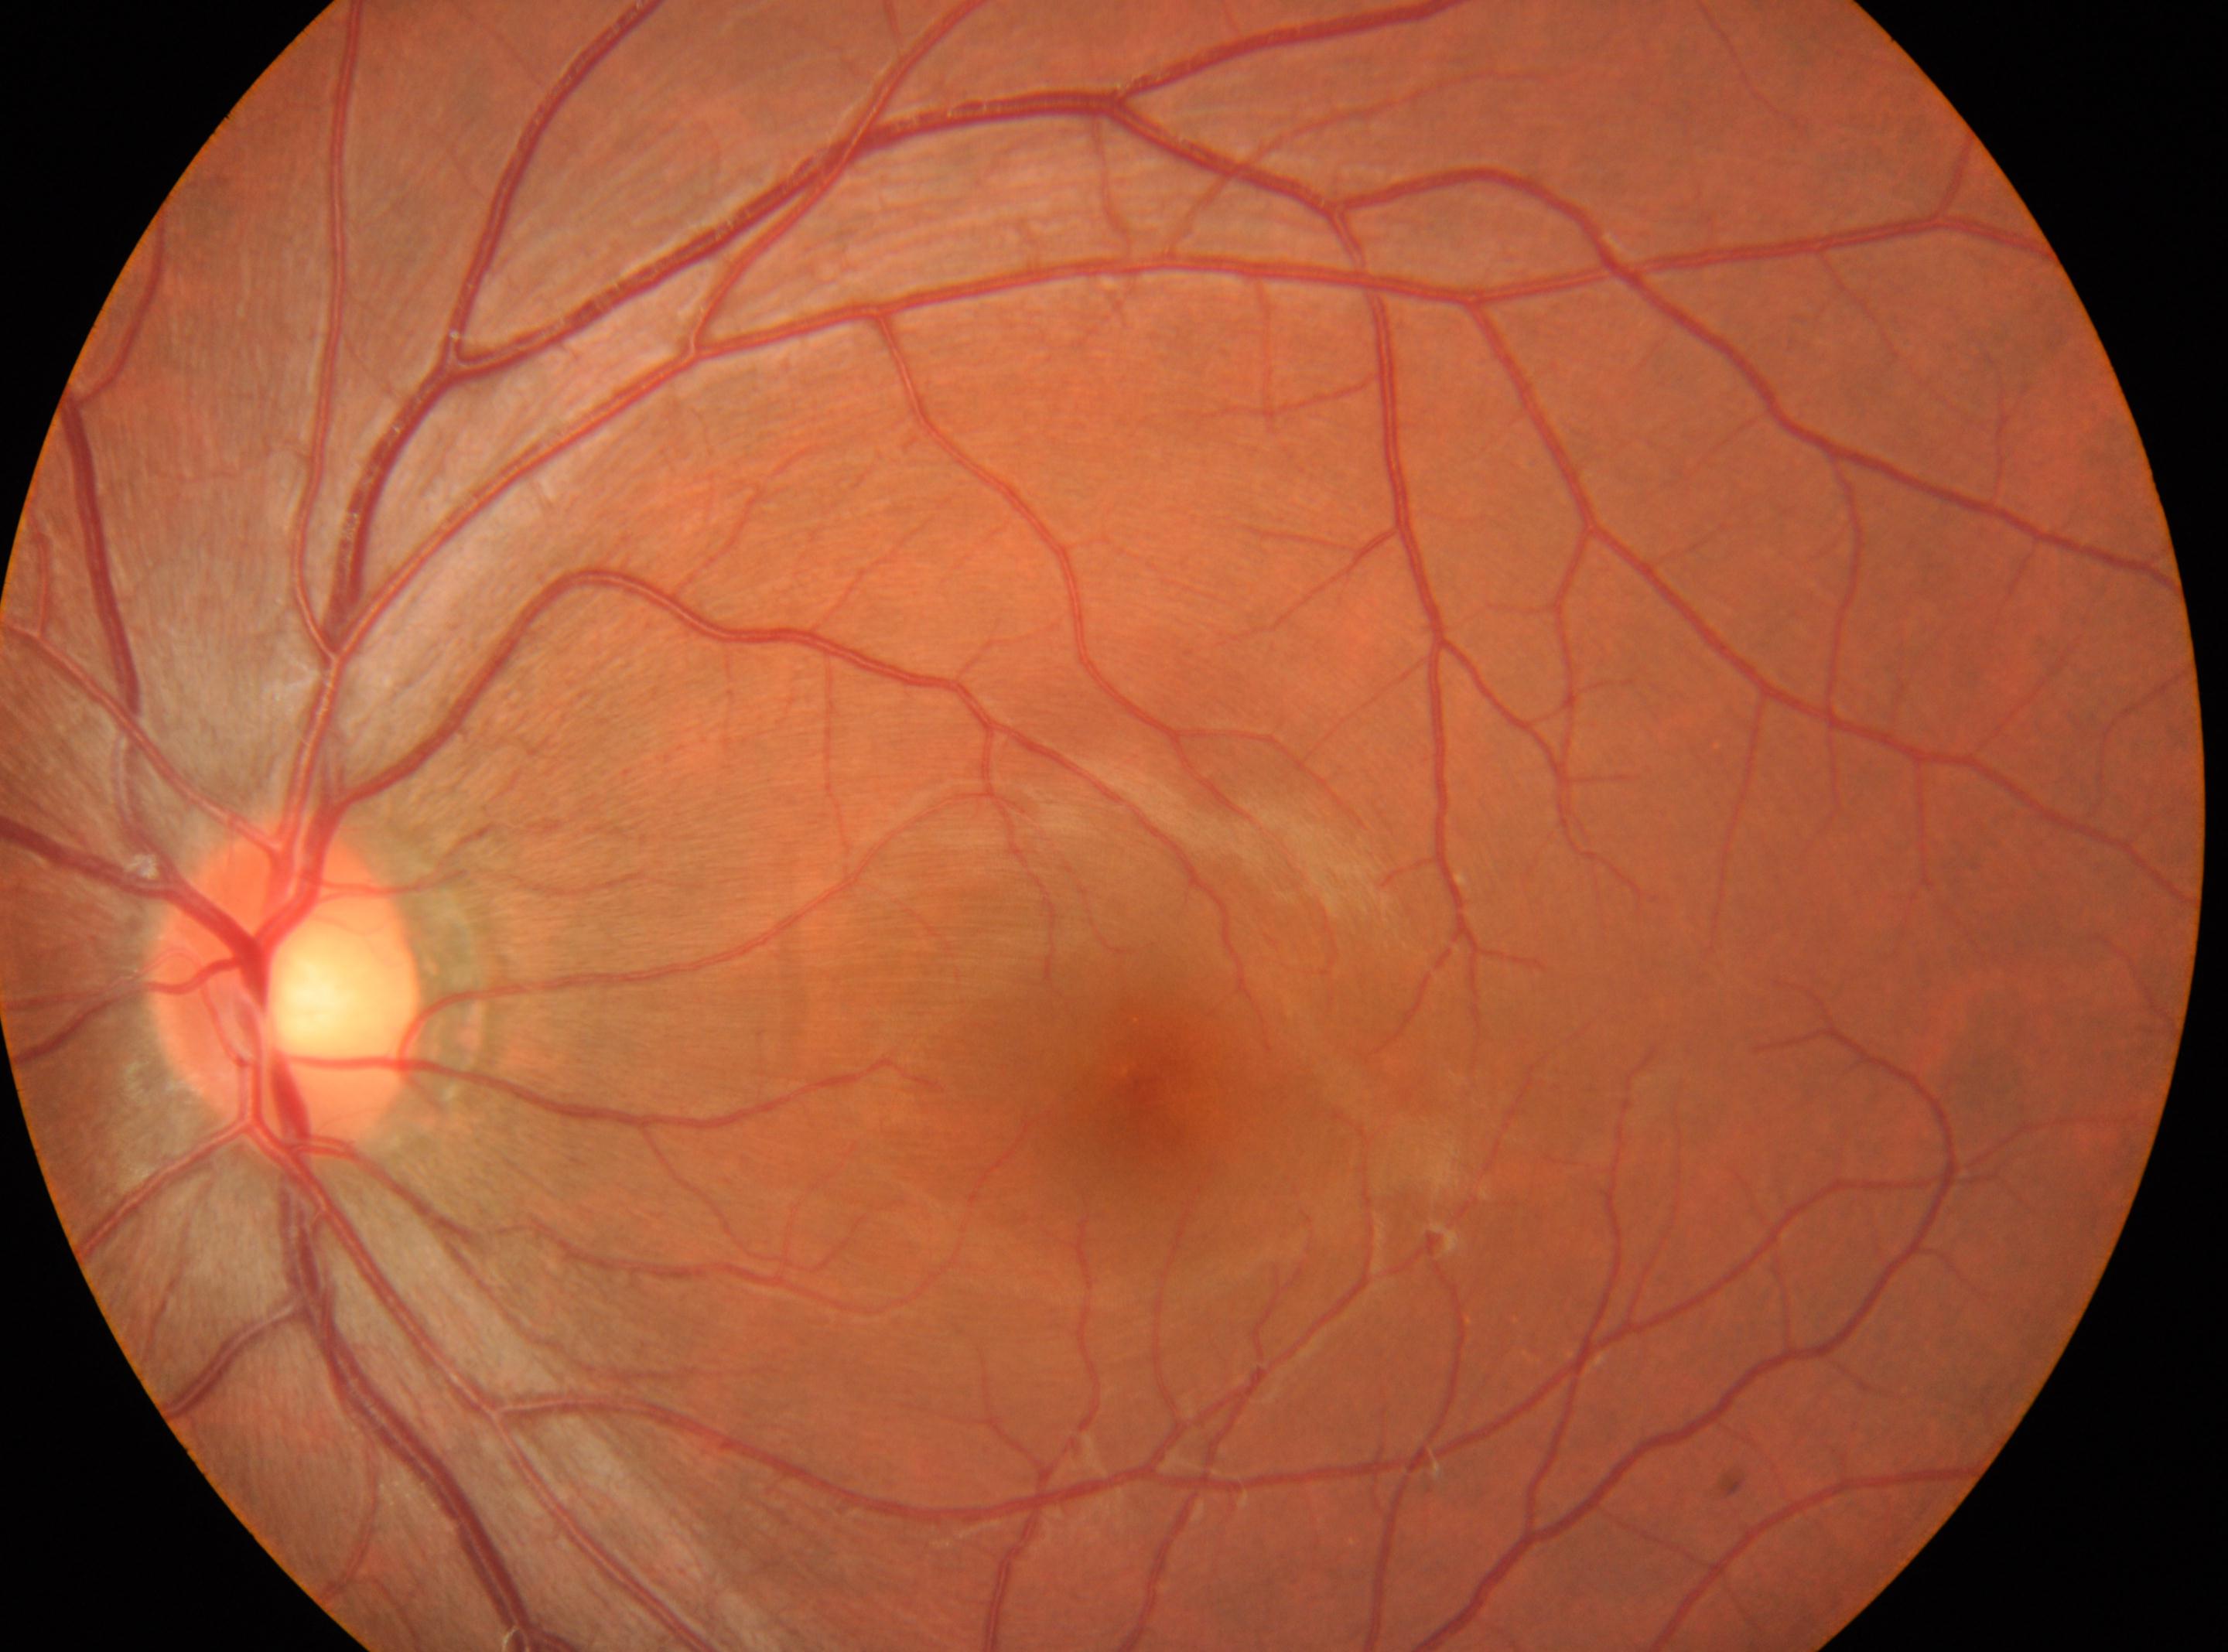 – DR stage · grade 0
– ONH · (x: 285, y: 982)
– laterality · the left eye
– DR impression · No diabetic retinal disease findings
– foveal center · (x: 1134, y: 1077)